Wide-field fundus photograph of an infant.
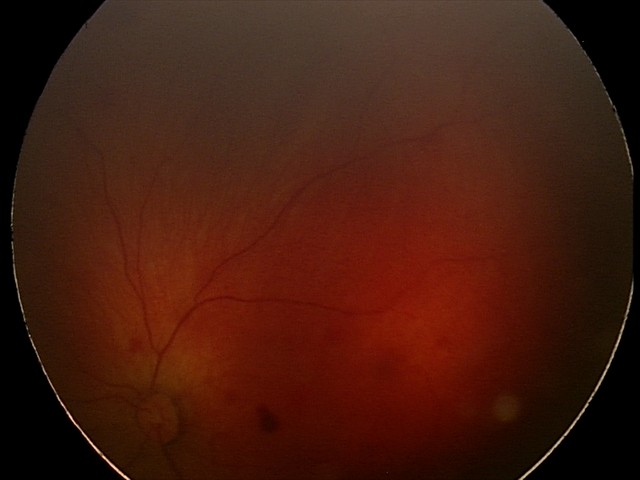 Screening series with retinal hemorrhages.